2352x1568px; 45-degree field of view; color fundus image — 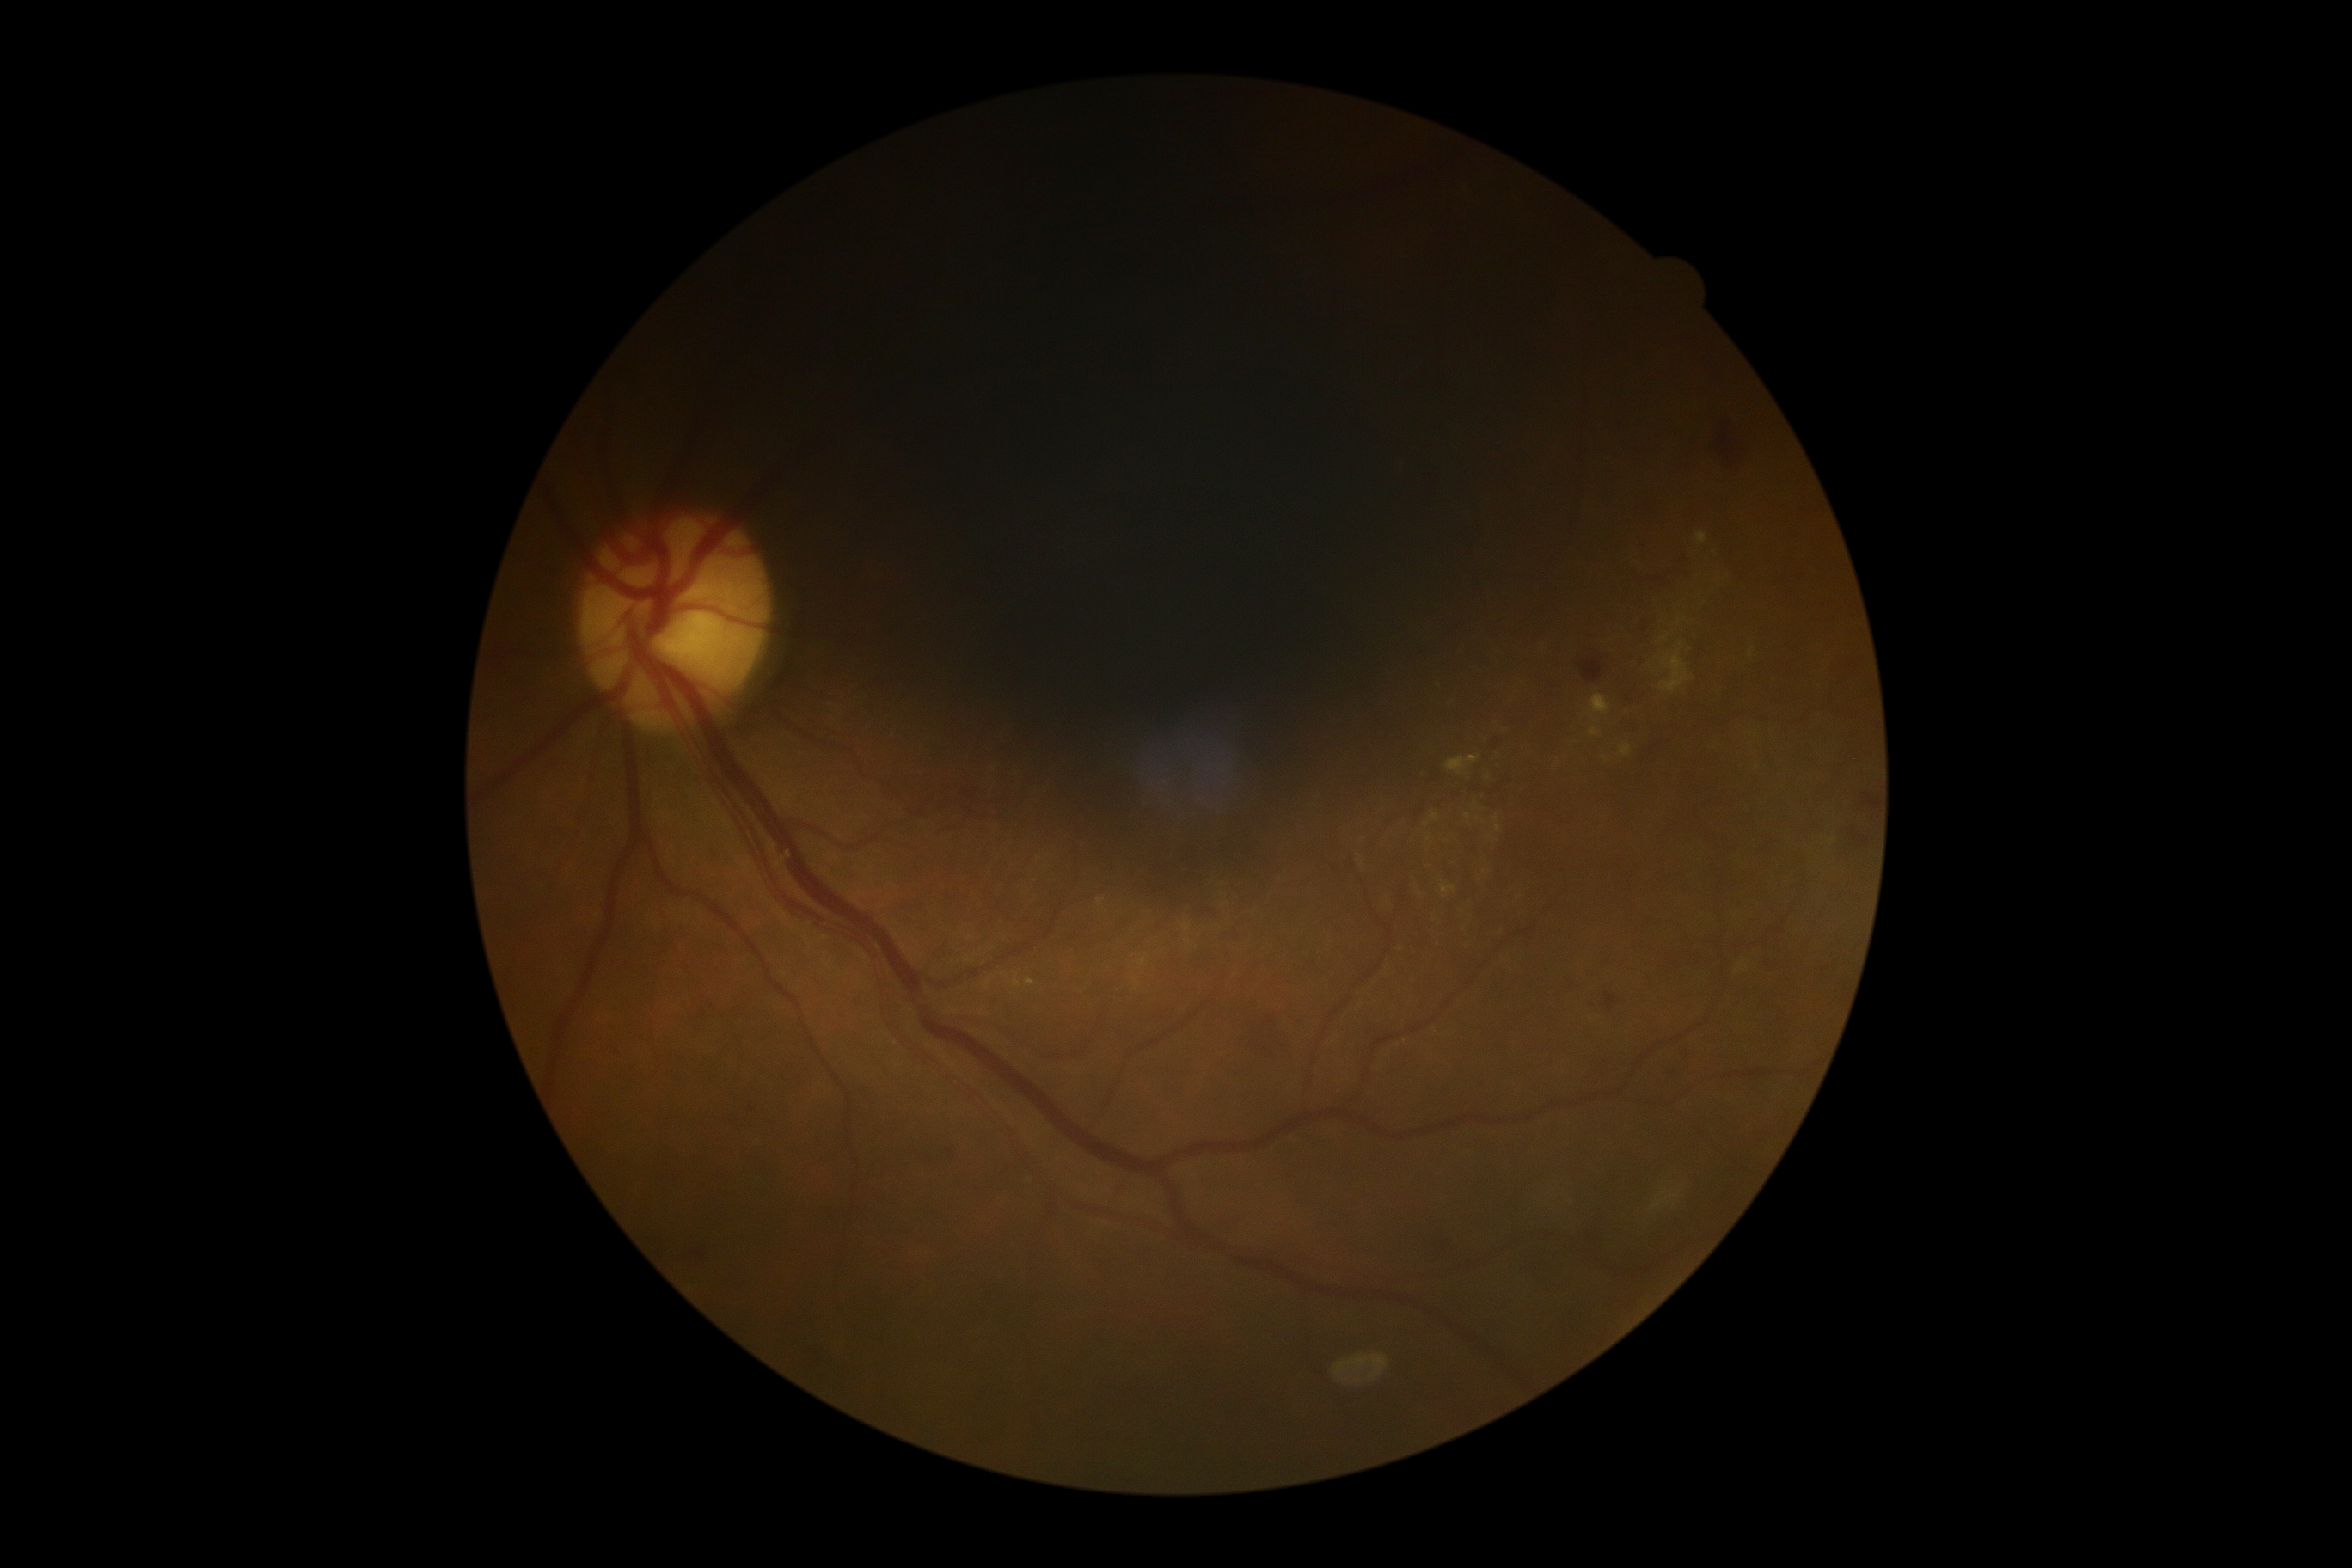 DR class: non-proliferative diabetic retinopathy; DR severity: grade 2 (moderate NPDR).